FOV: 45 degrees:
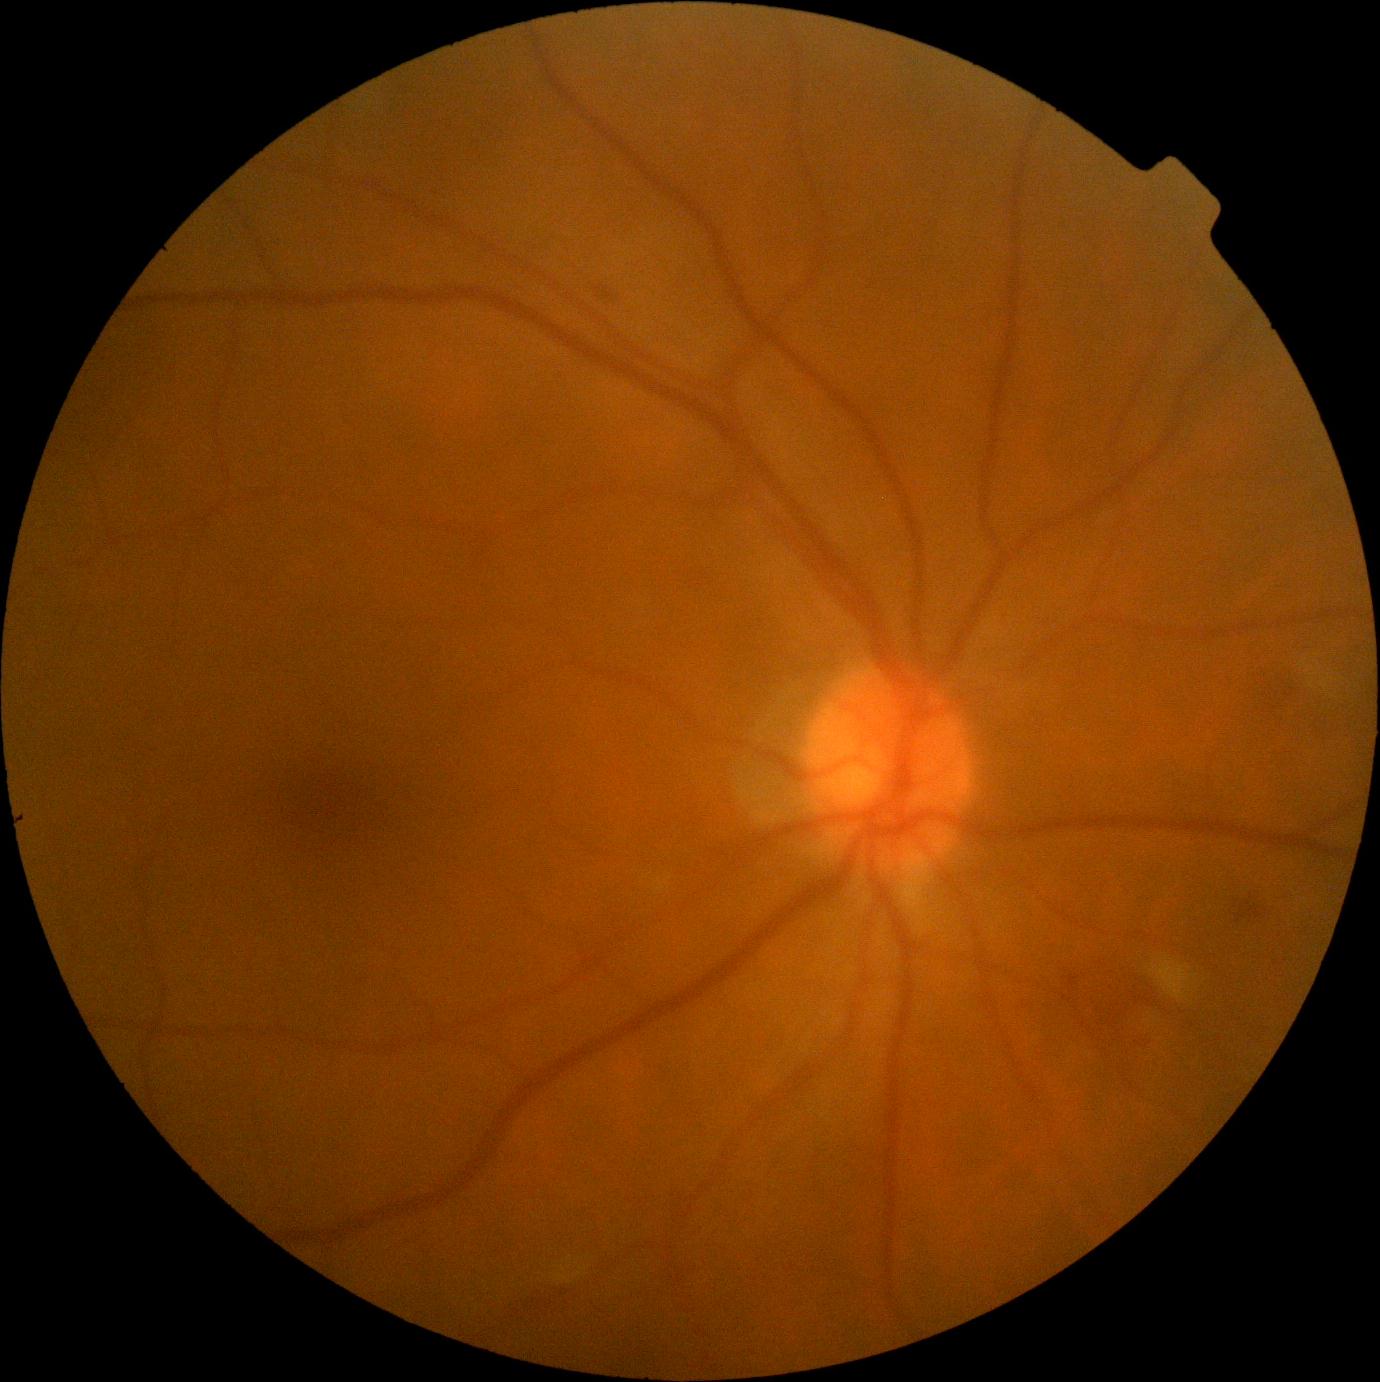 DR stage is 2.